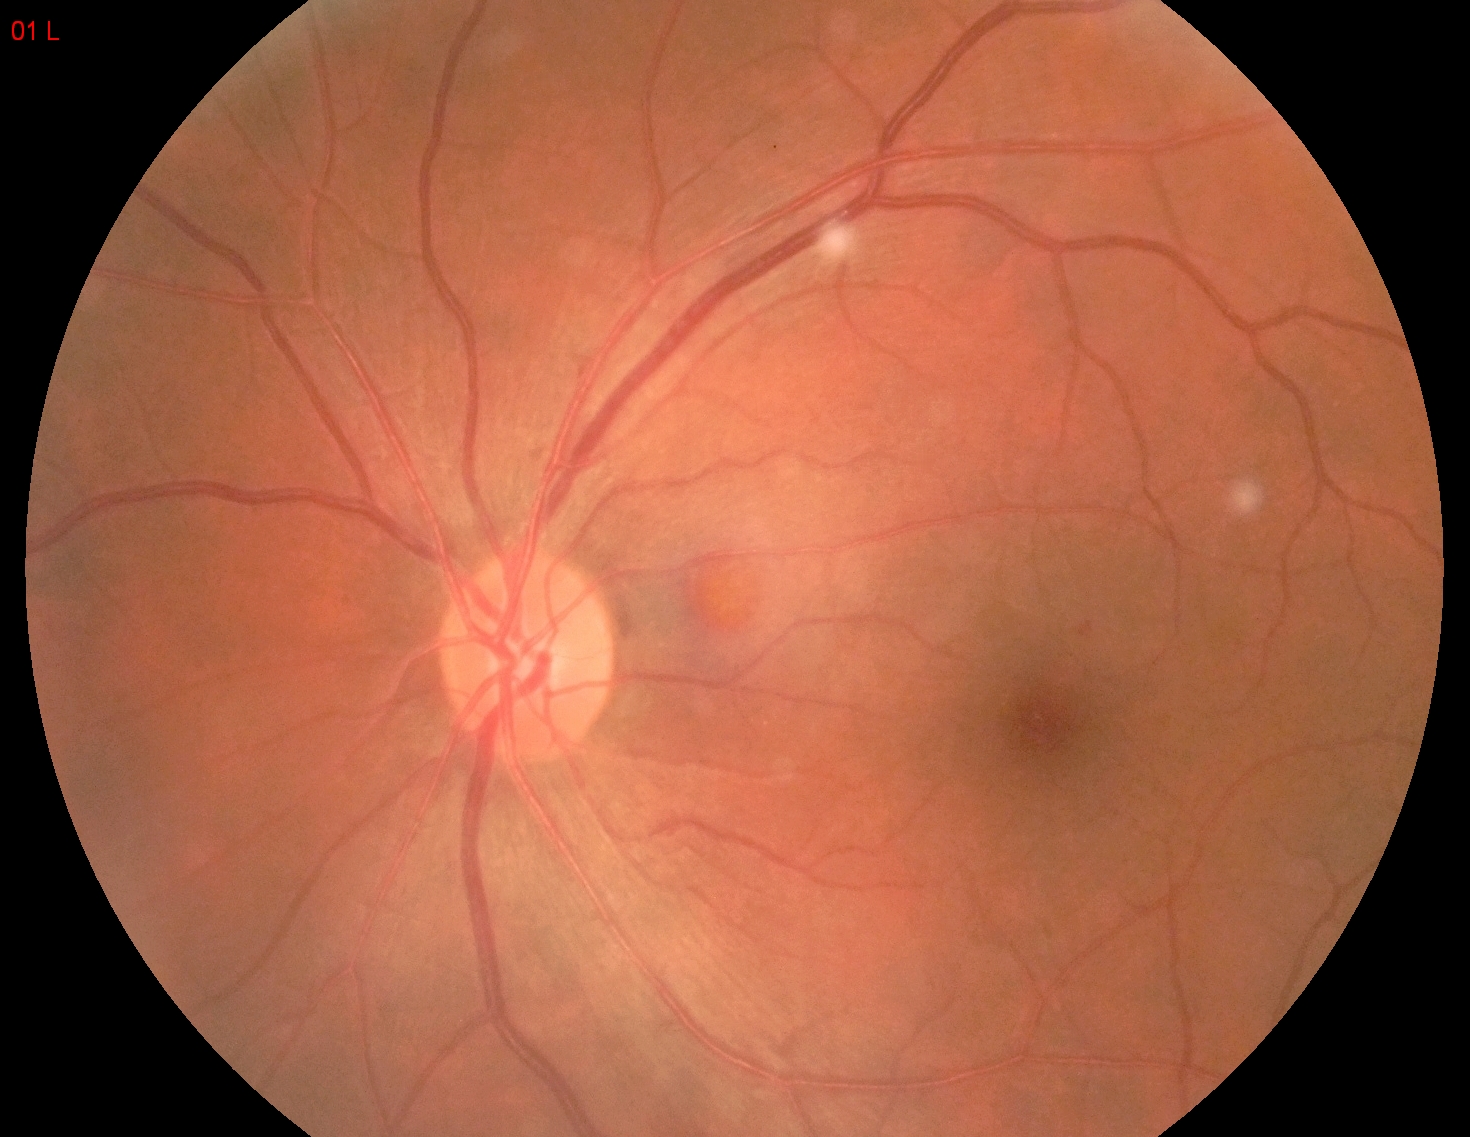

DR grade = 1
DR class = non-proliferative diabetic retinopathy